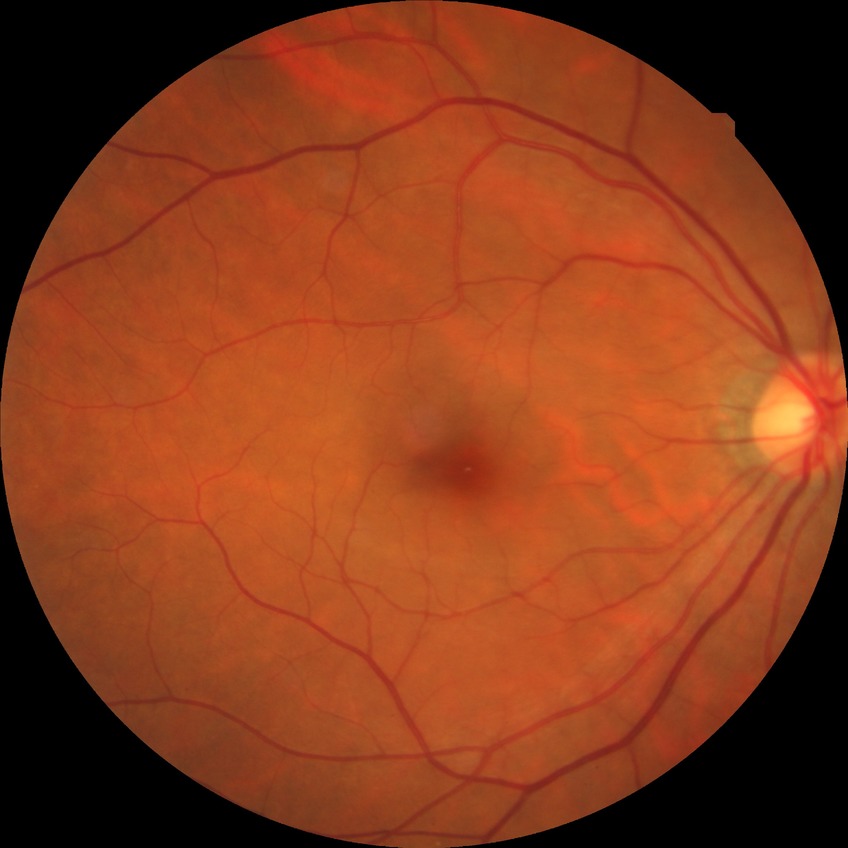
Diabetic retinopathy severity: no diabetic retinopathy.